Diabetic retinopathy graded by the modified Davis classification — 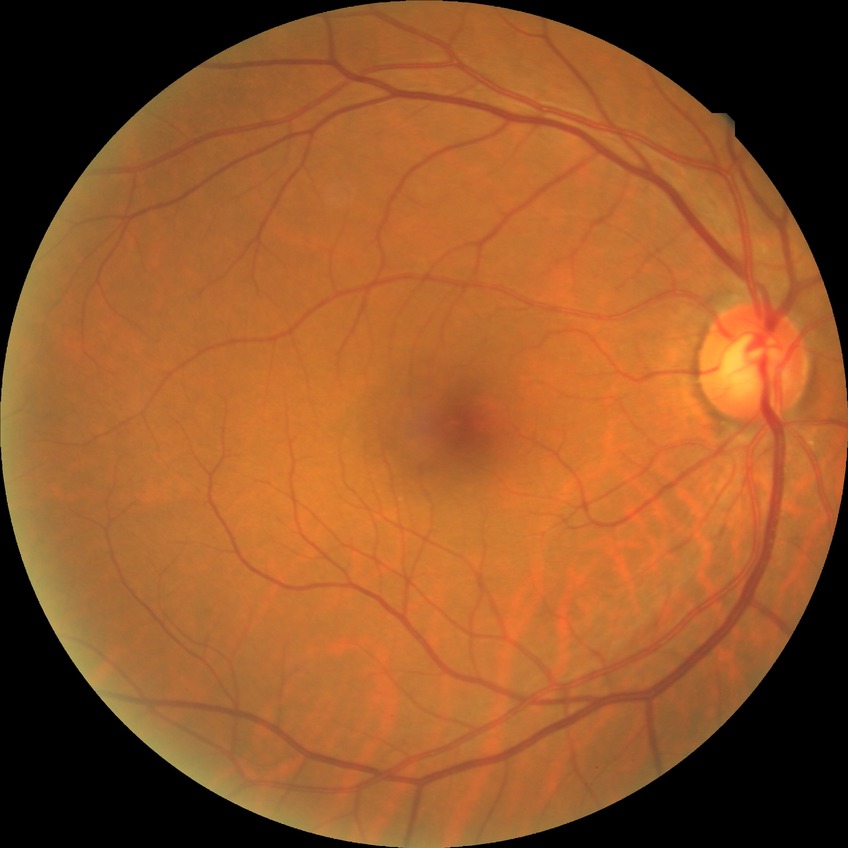
Davis DR grade is NDR.
No signs of diabetic retinopathy.